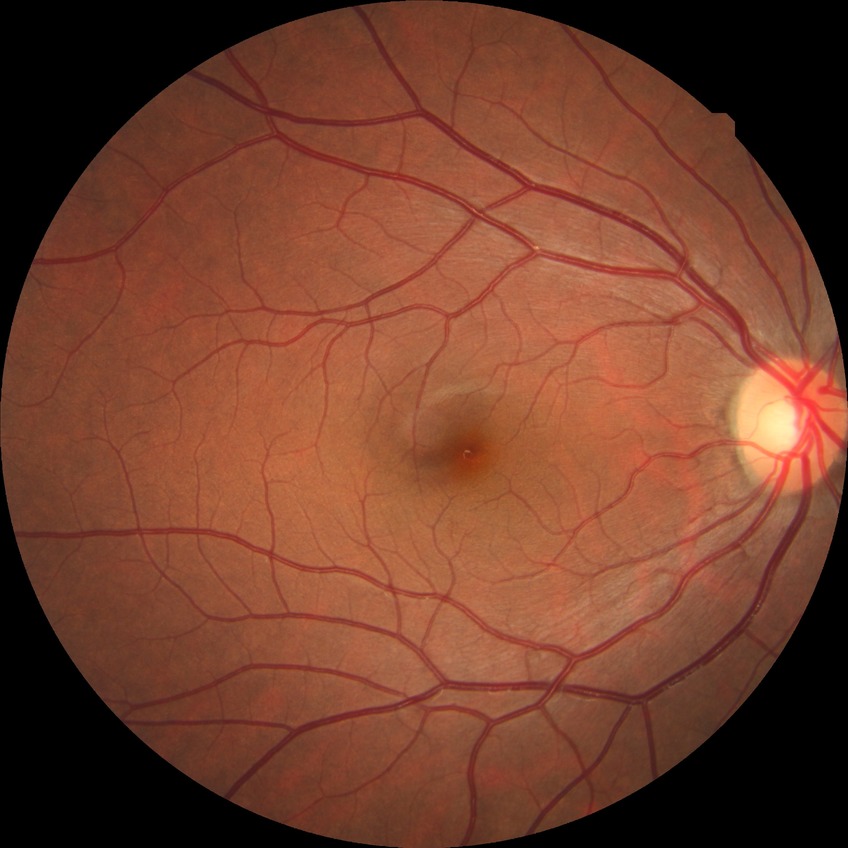 Retinopathy grade is no diabetic retinopathy.